2212 by 1659 pixels · color fundus image — 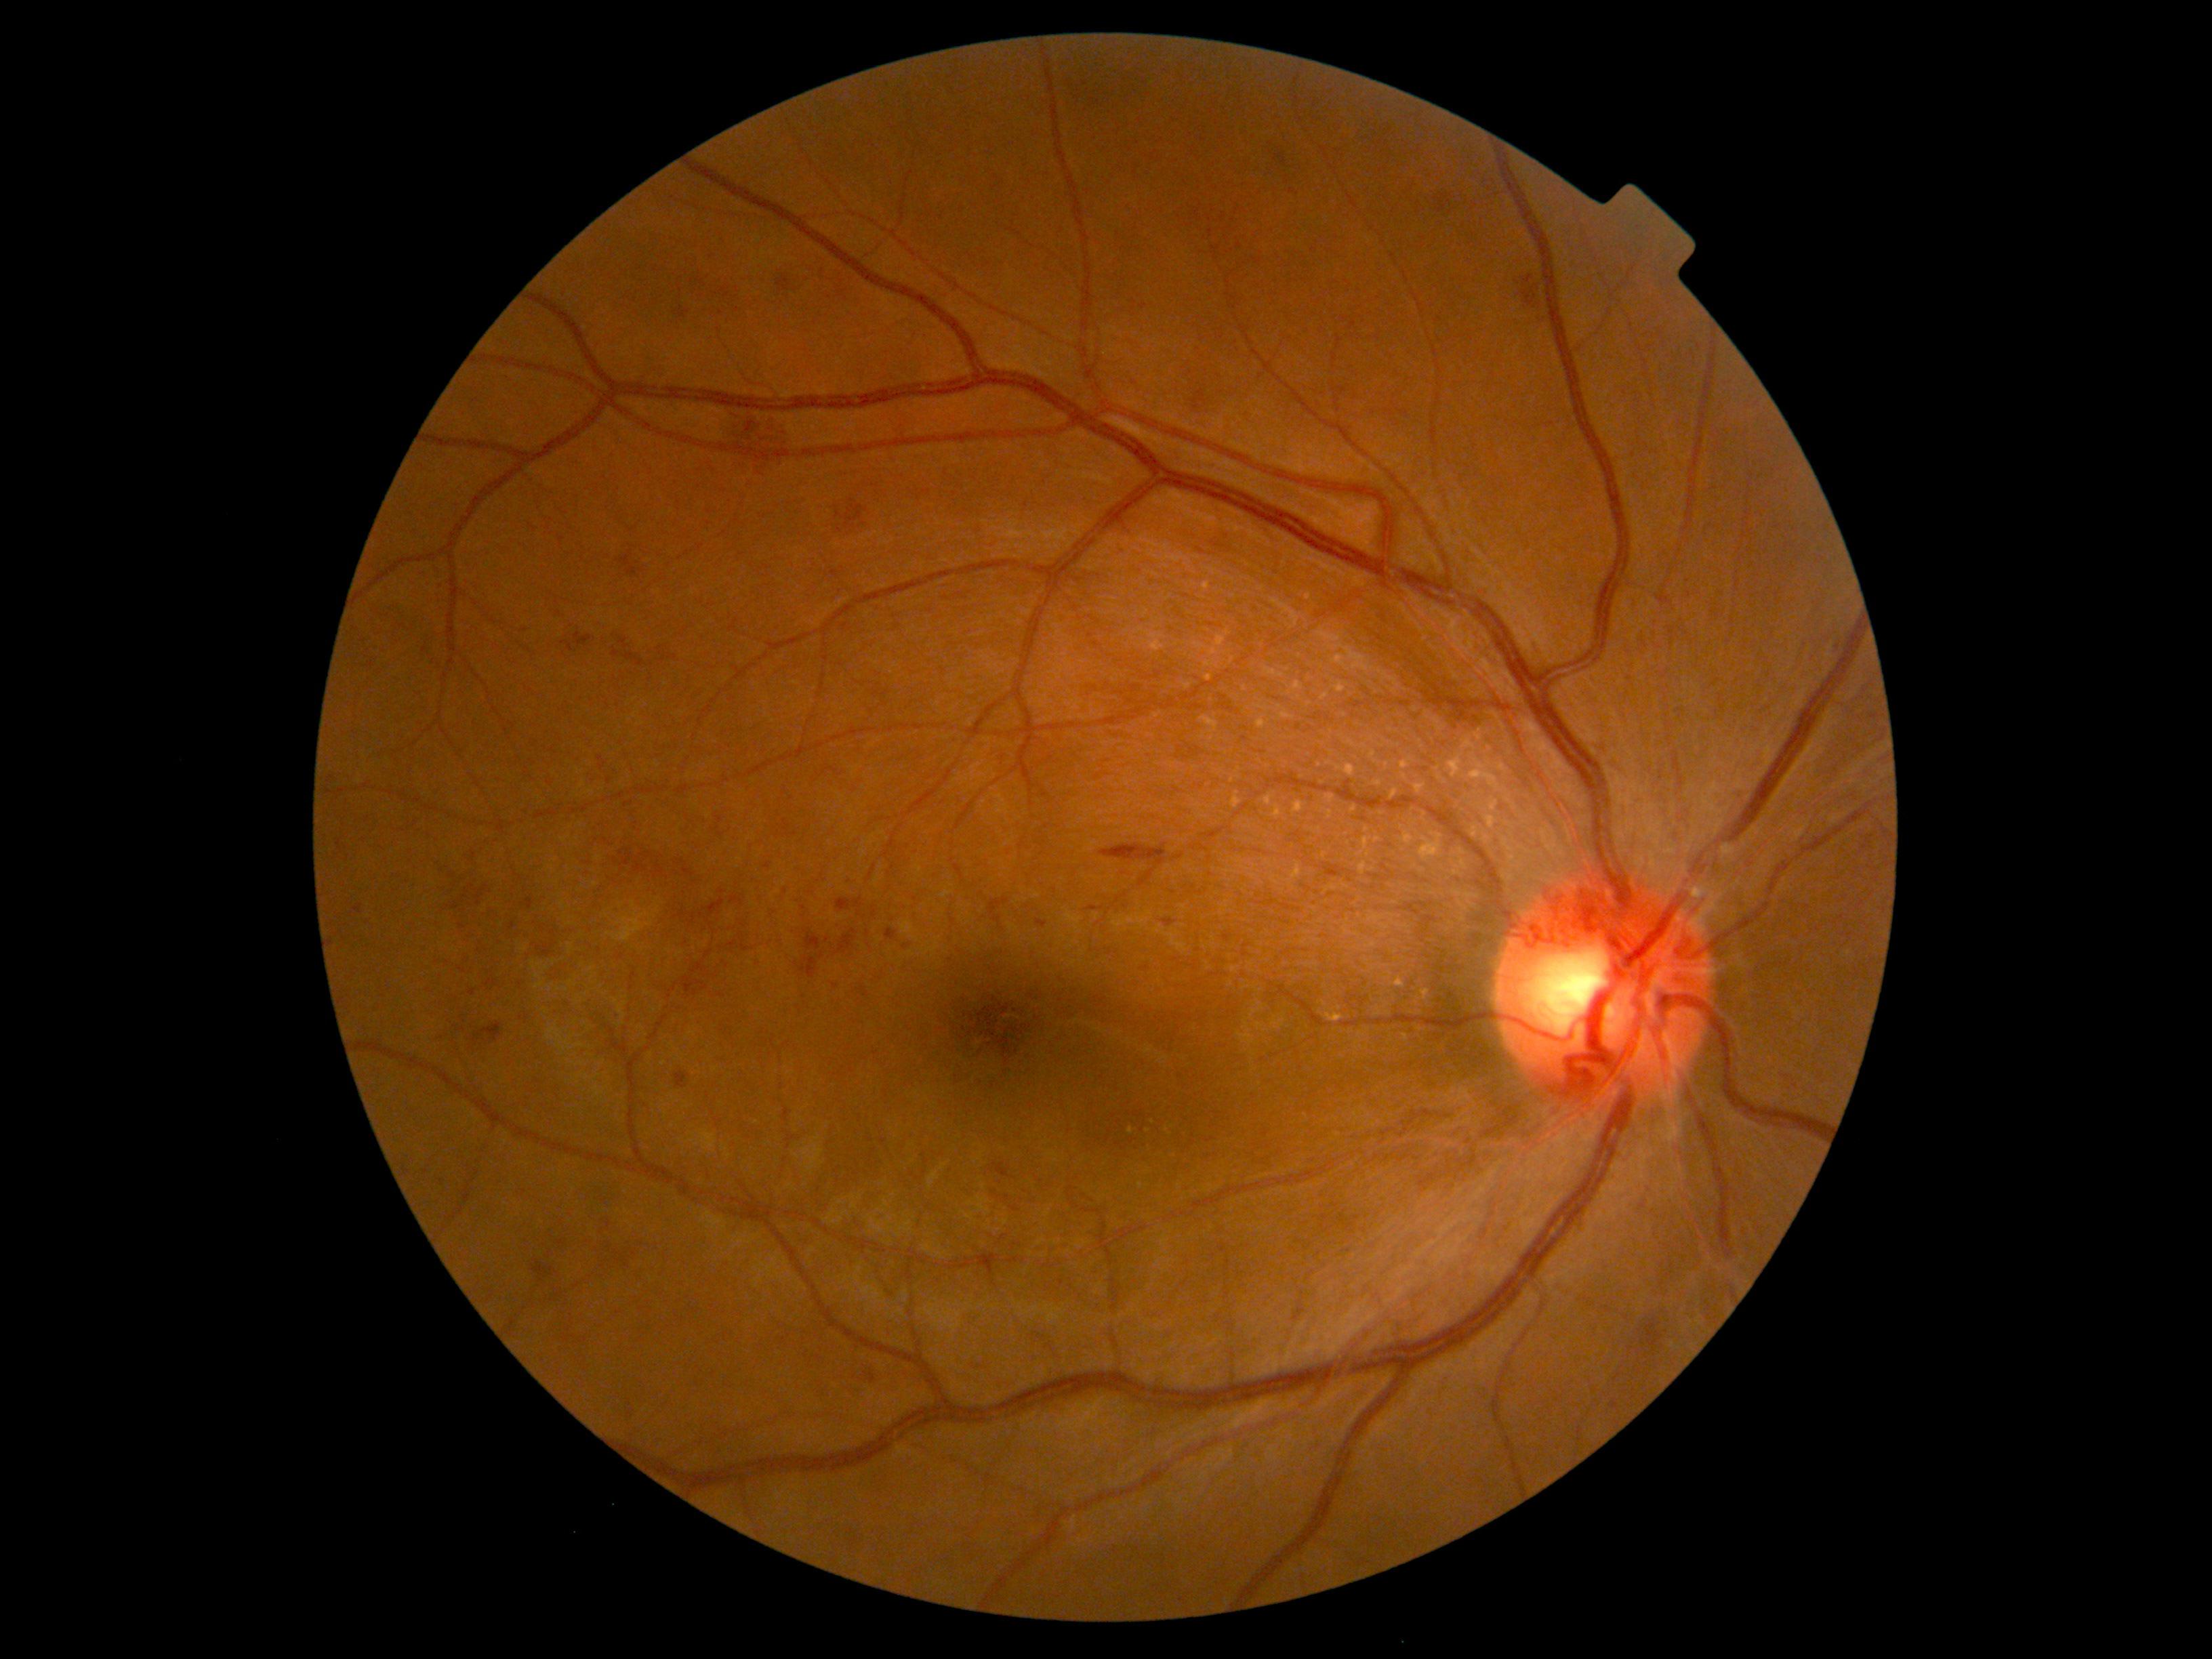 {"partial": true, "dr_grade": 2, "lesions": {"ex": [[1390, 978, 1406, 989], [1420, 989, 1432, 997], [1325, 1012, 1345, 1023]], "ex_small": [[1167, 1130], [1130, 1130]], "se": null, "he": [[886, 928, 898, 940], [486, 979, 498, 987], [457, 967, 467, 974], [676, 860, 695, 876], [472, 1023, 502, 1046], [1435, 193, 1455, 219], [722, 411, 791, 482], [635, 852, 653, 872], [619, 849, 634, 865], [1641, 1199, 1650, 1212], [658, 646, 662, 654], [708, 253, 719, 261]], "he_small": [[371, 665], [796, 964], [471, 886], [520, 984], [821, 955], [835, 986]], "ma": null}}